45° FOV, fundus photo, 2048 x 1536 pixels:
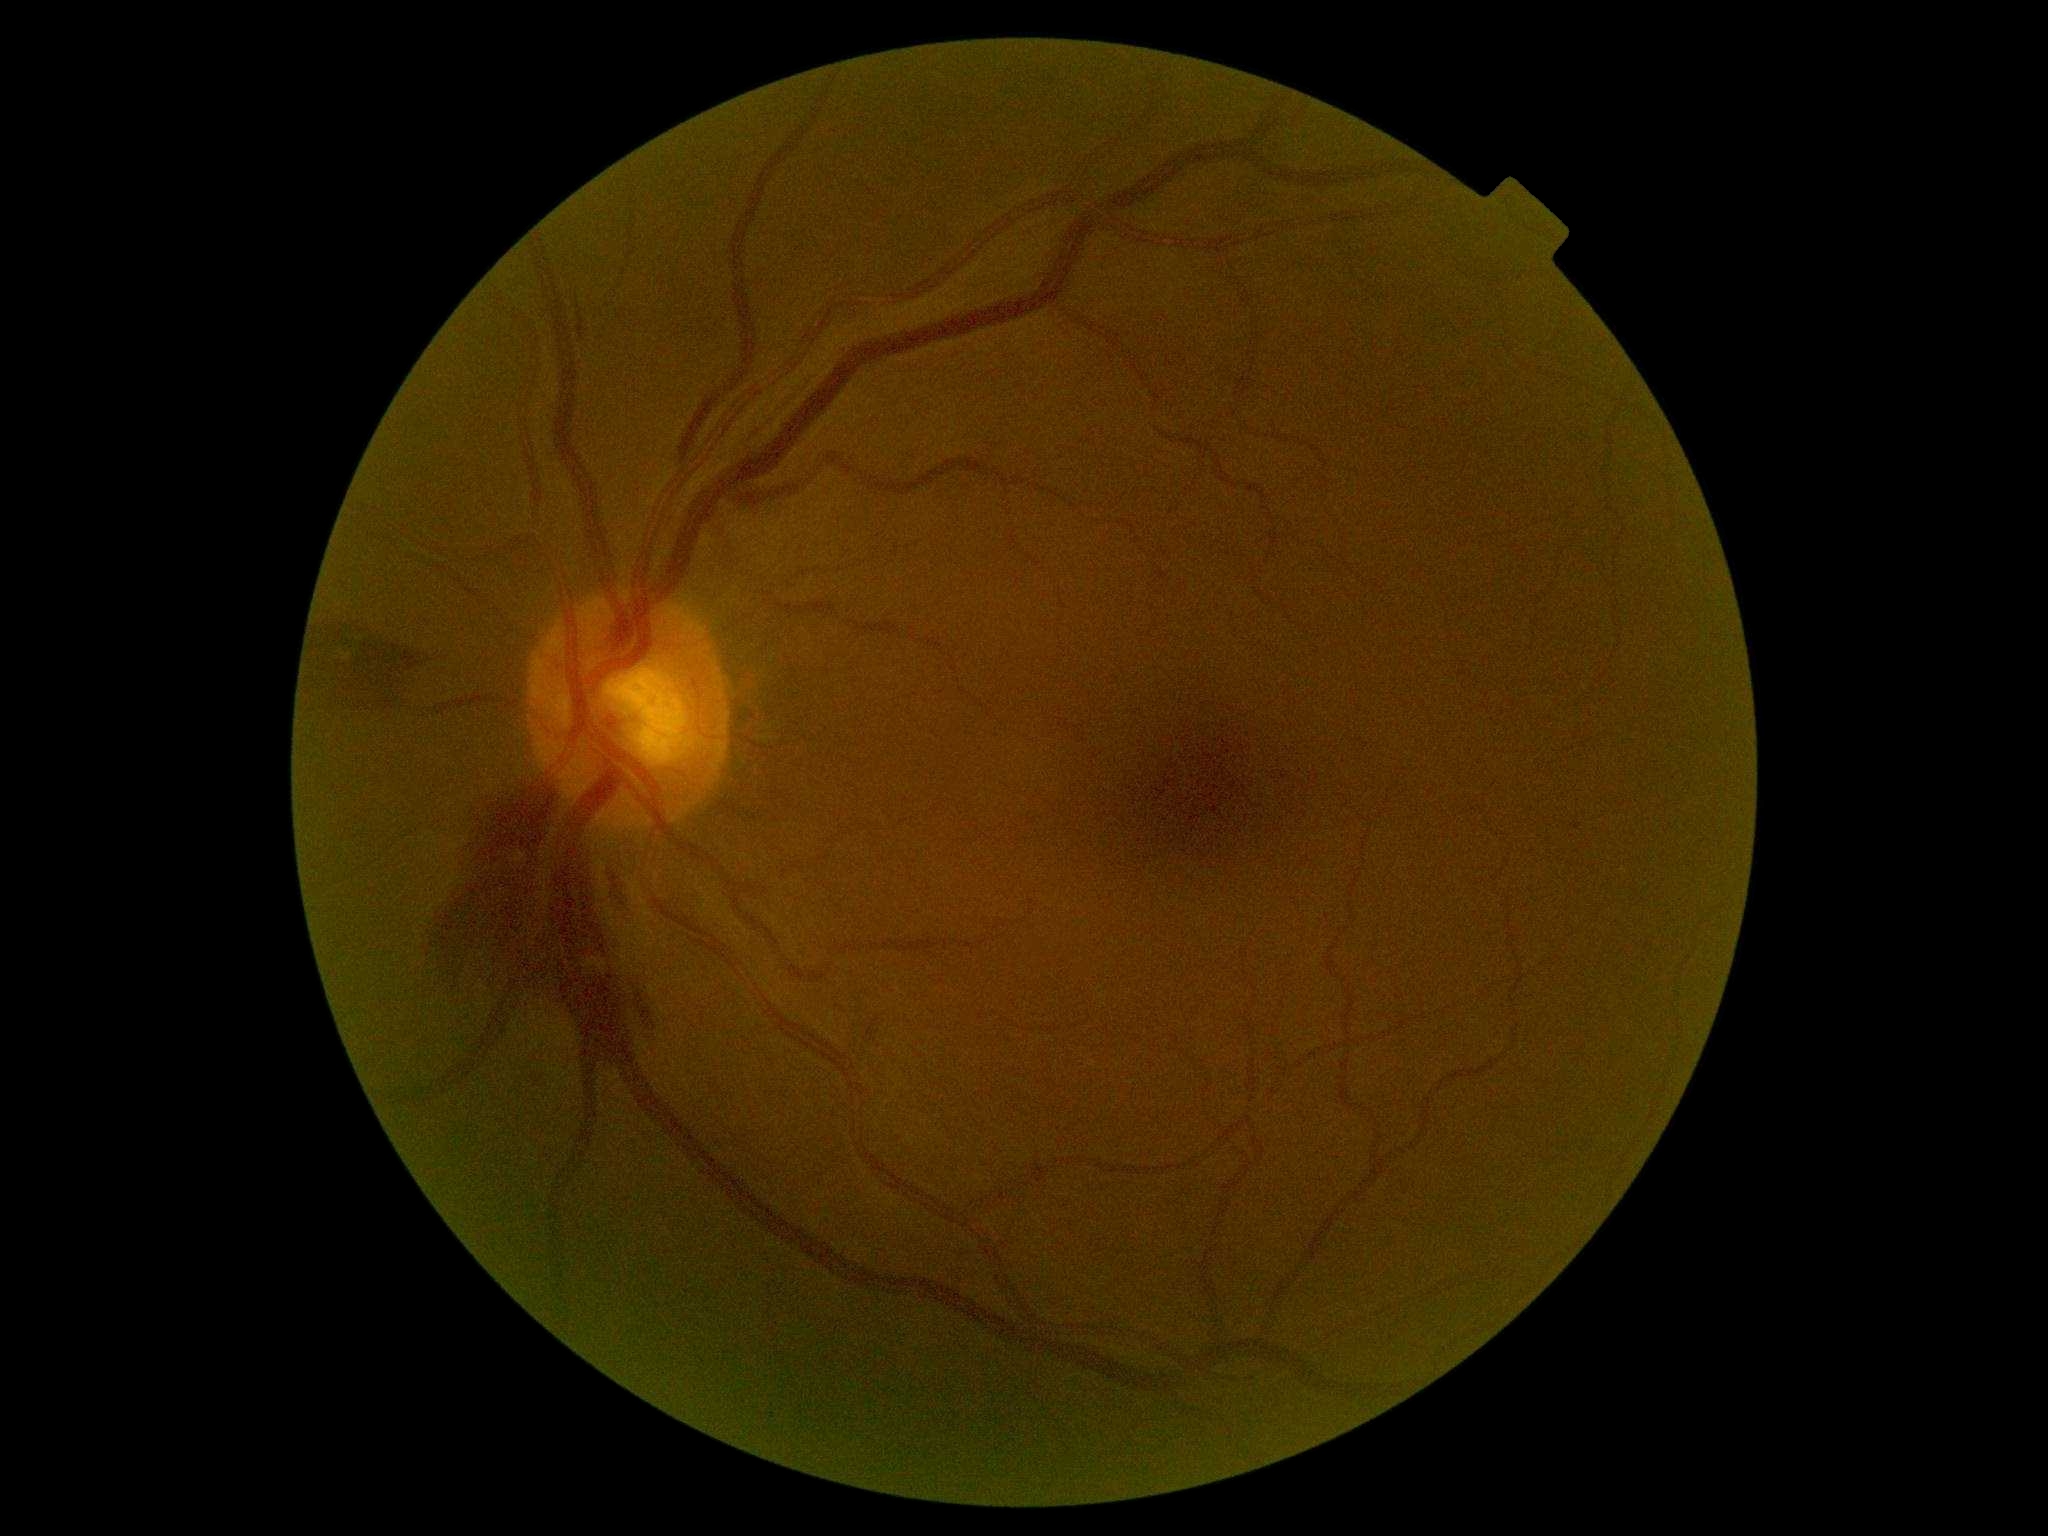 Retinopathy: grade 2 (moderate NPDR).